45-degree field of view, fundus photo: 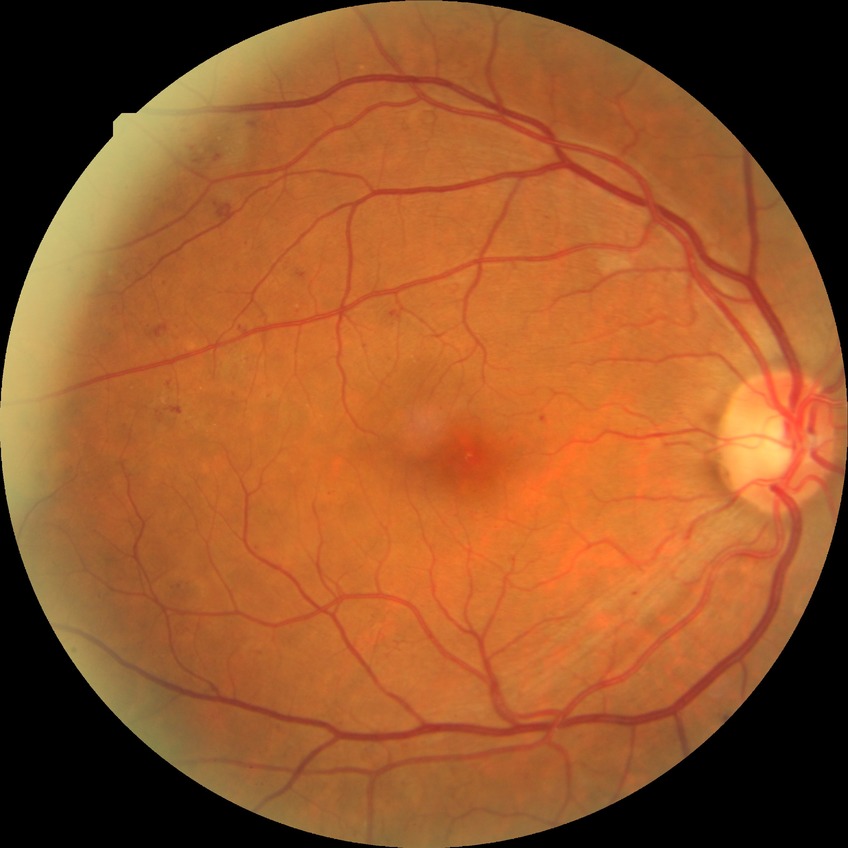

diabetic retinopathy (DR): PPDR (pre-proliferative diabetic retinopathy).